Captured with the Clarity RetCam 3 (130° field of view); infant wide-field fundus photograph: 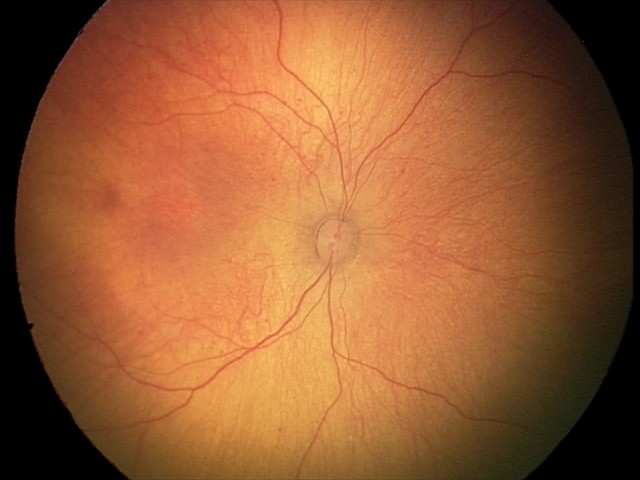 Screening: physiological appearance with no retinal pathology.